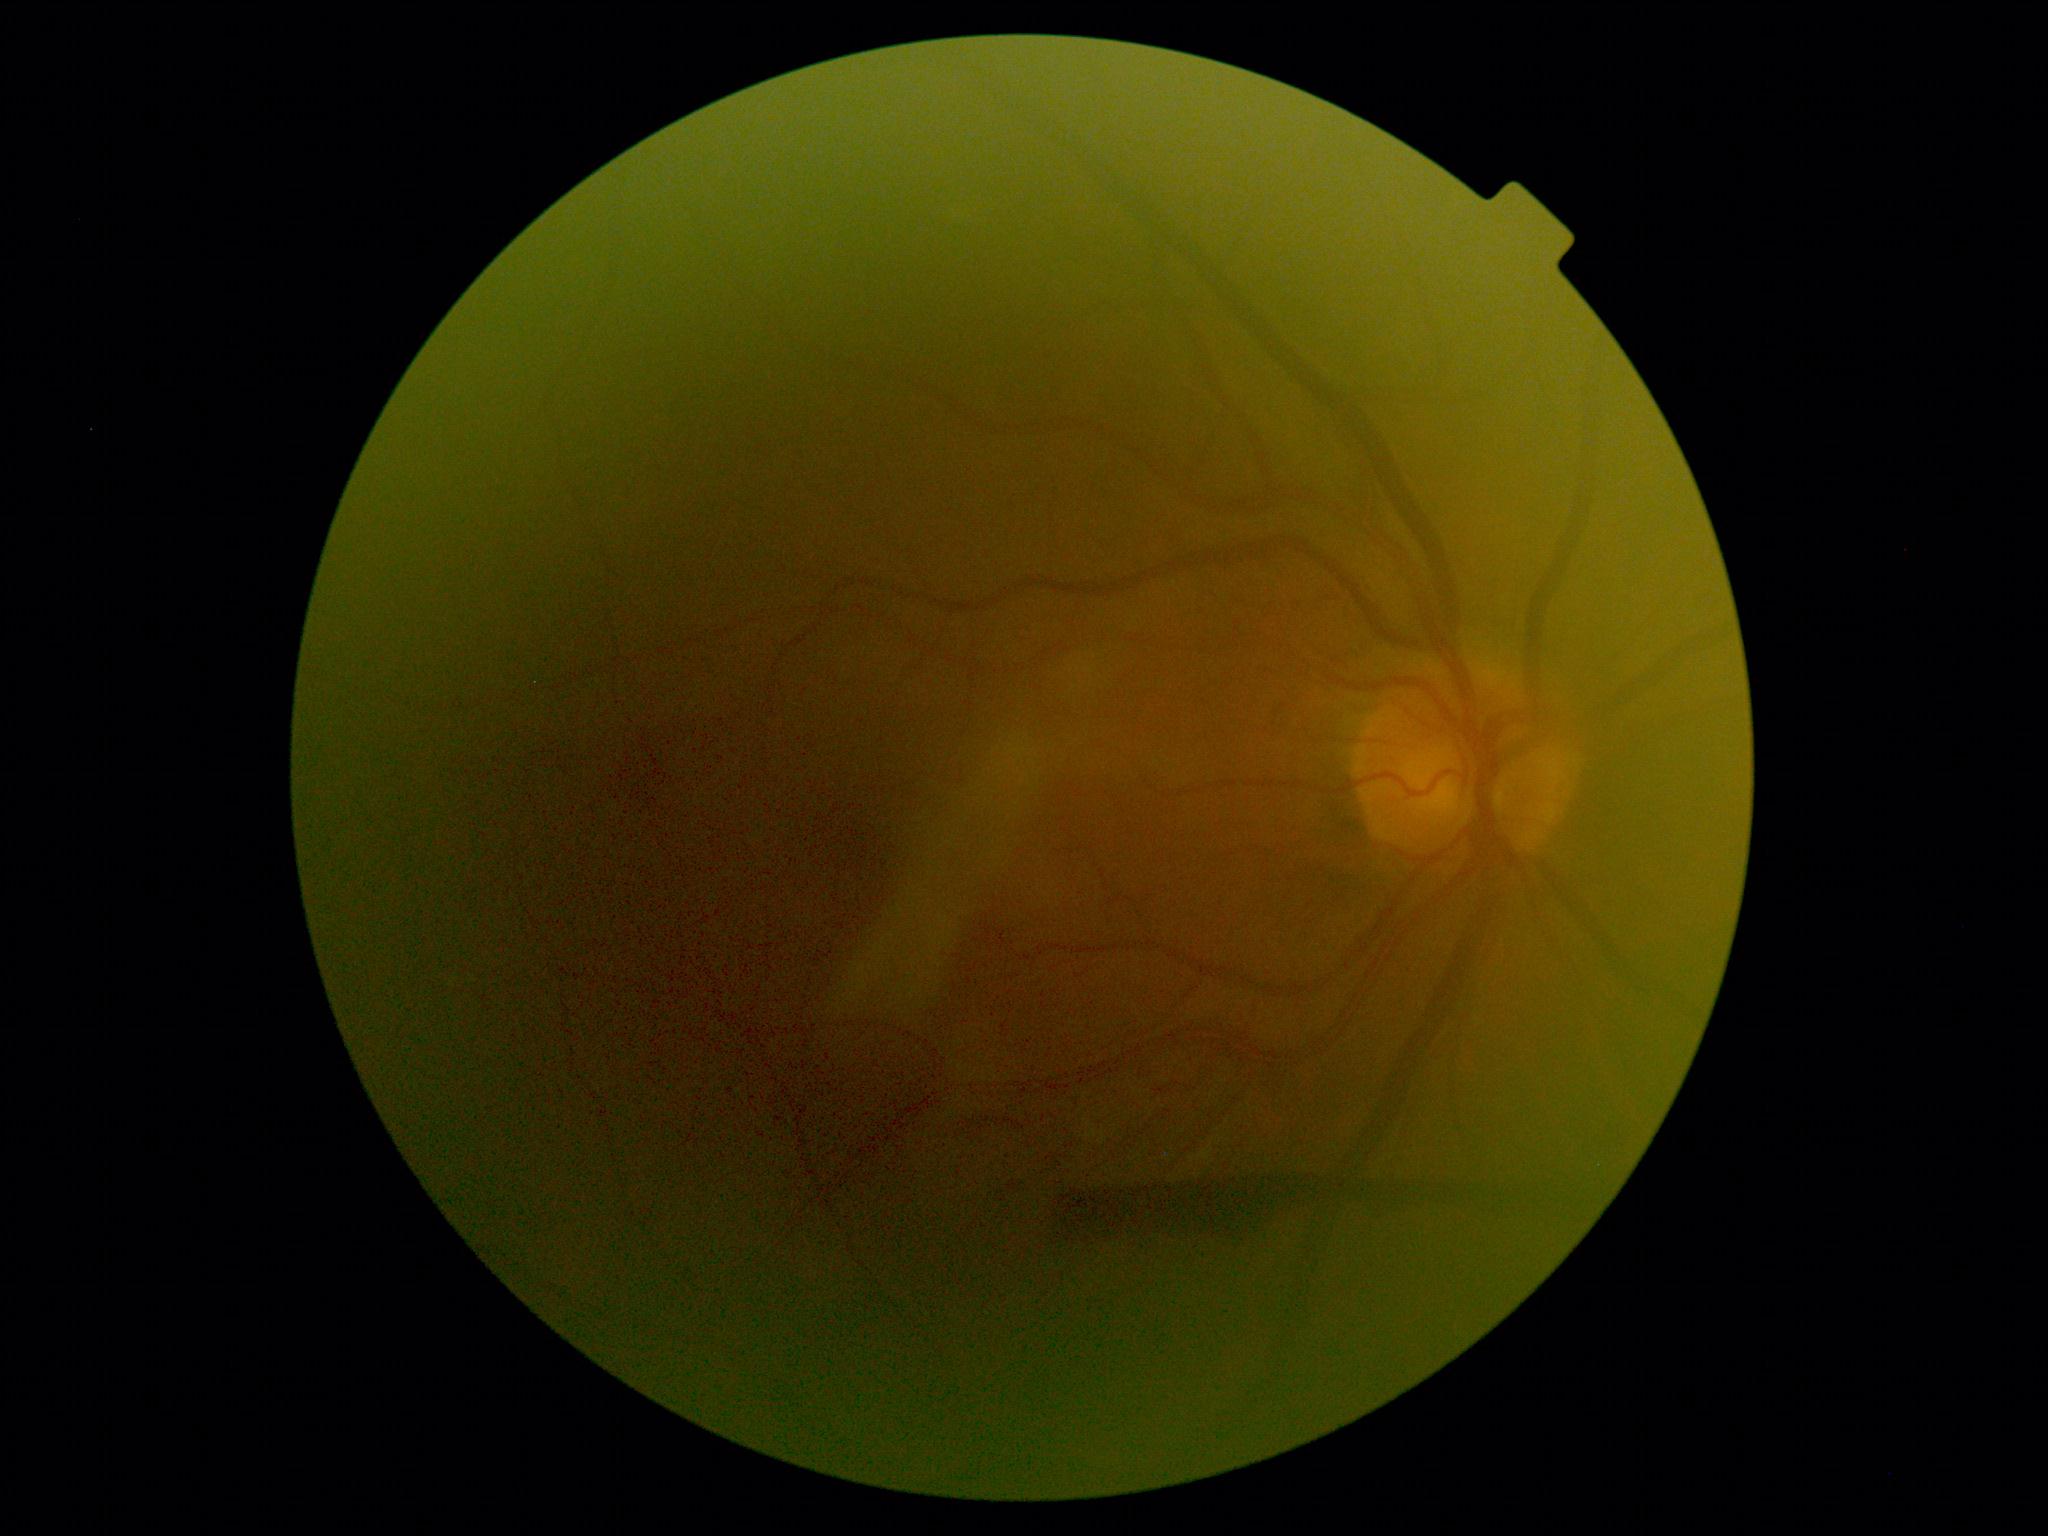
DR stage: 4/4. The retinopathy is classified as proliferative diabetic retinopathy.